45-degree field of view.
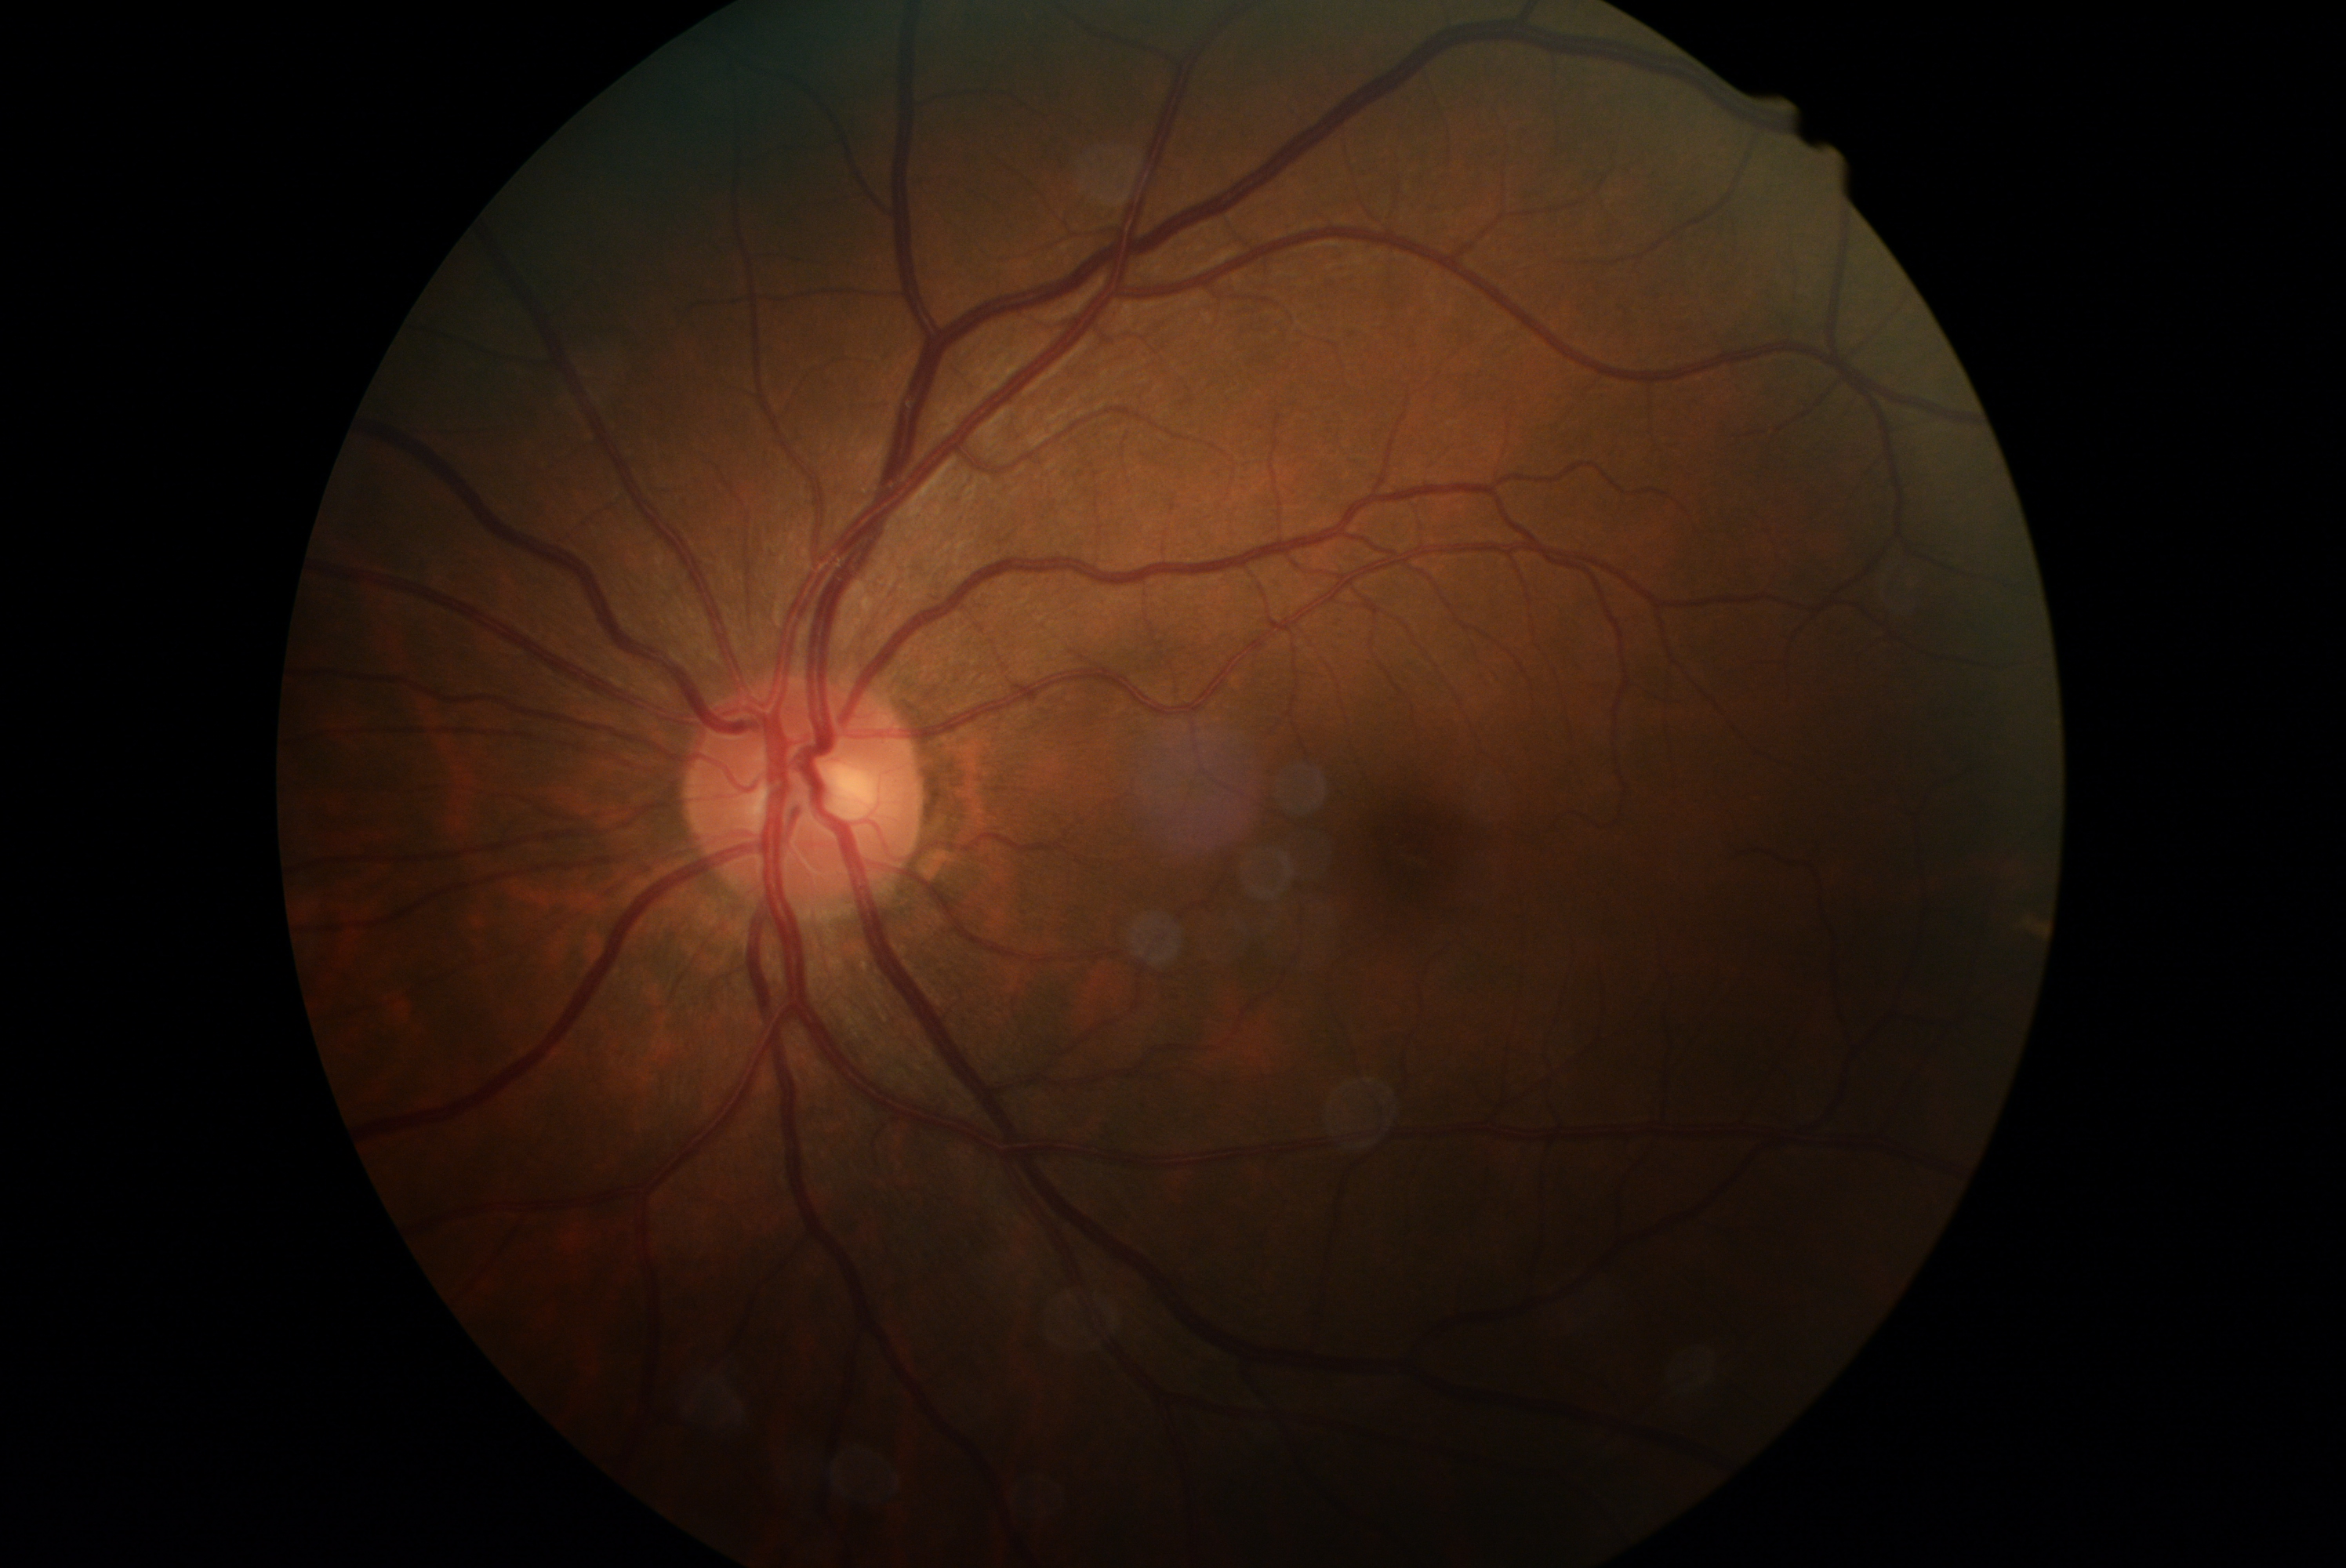
Diabetic retinopathy grade: no apparent diabetic retinopathy (0). No diabetic retinal disease findings.